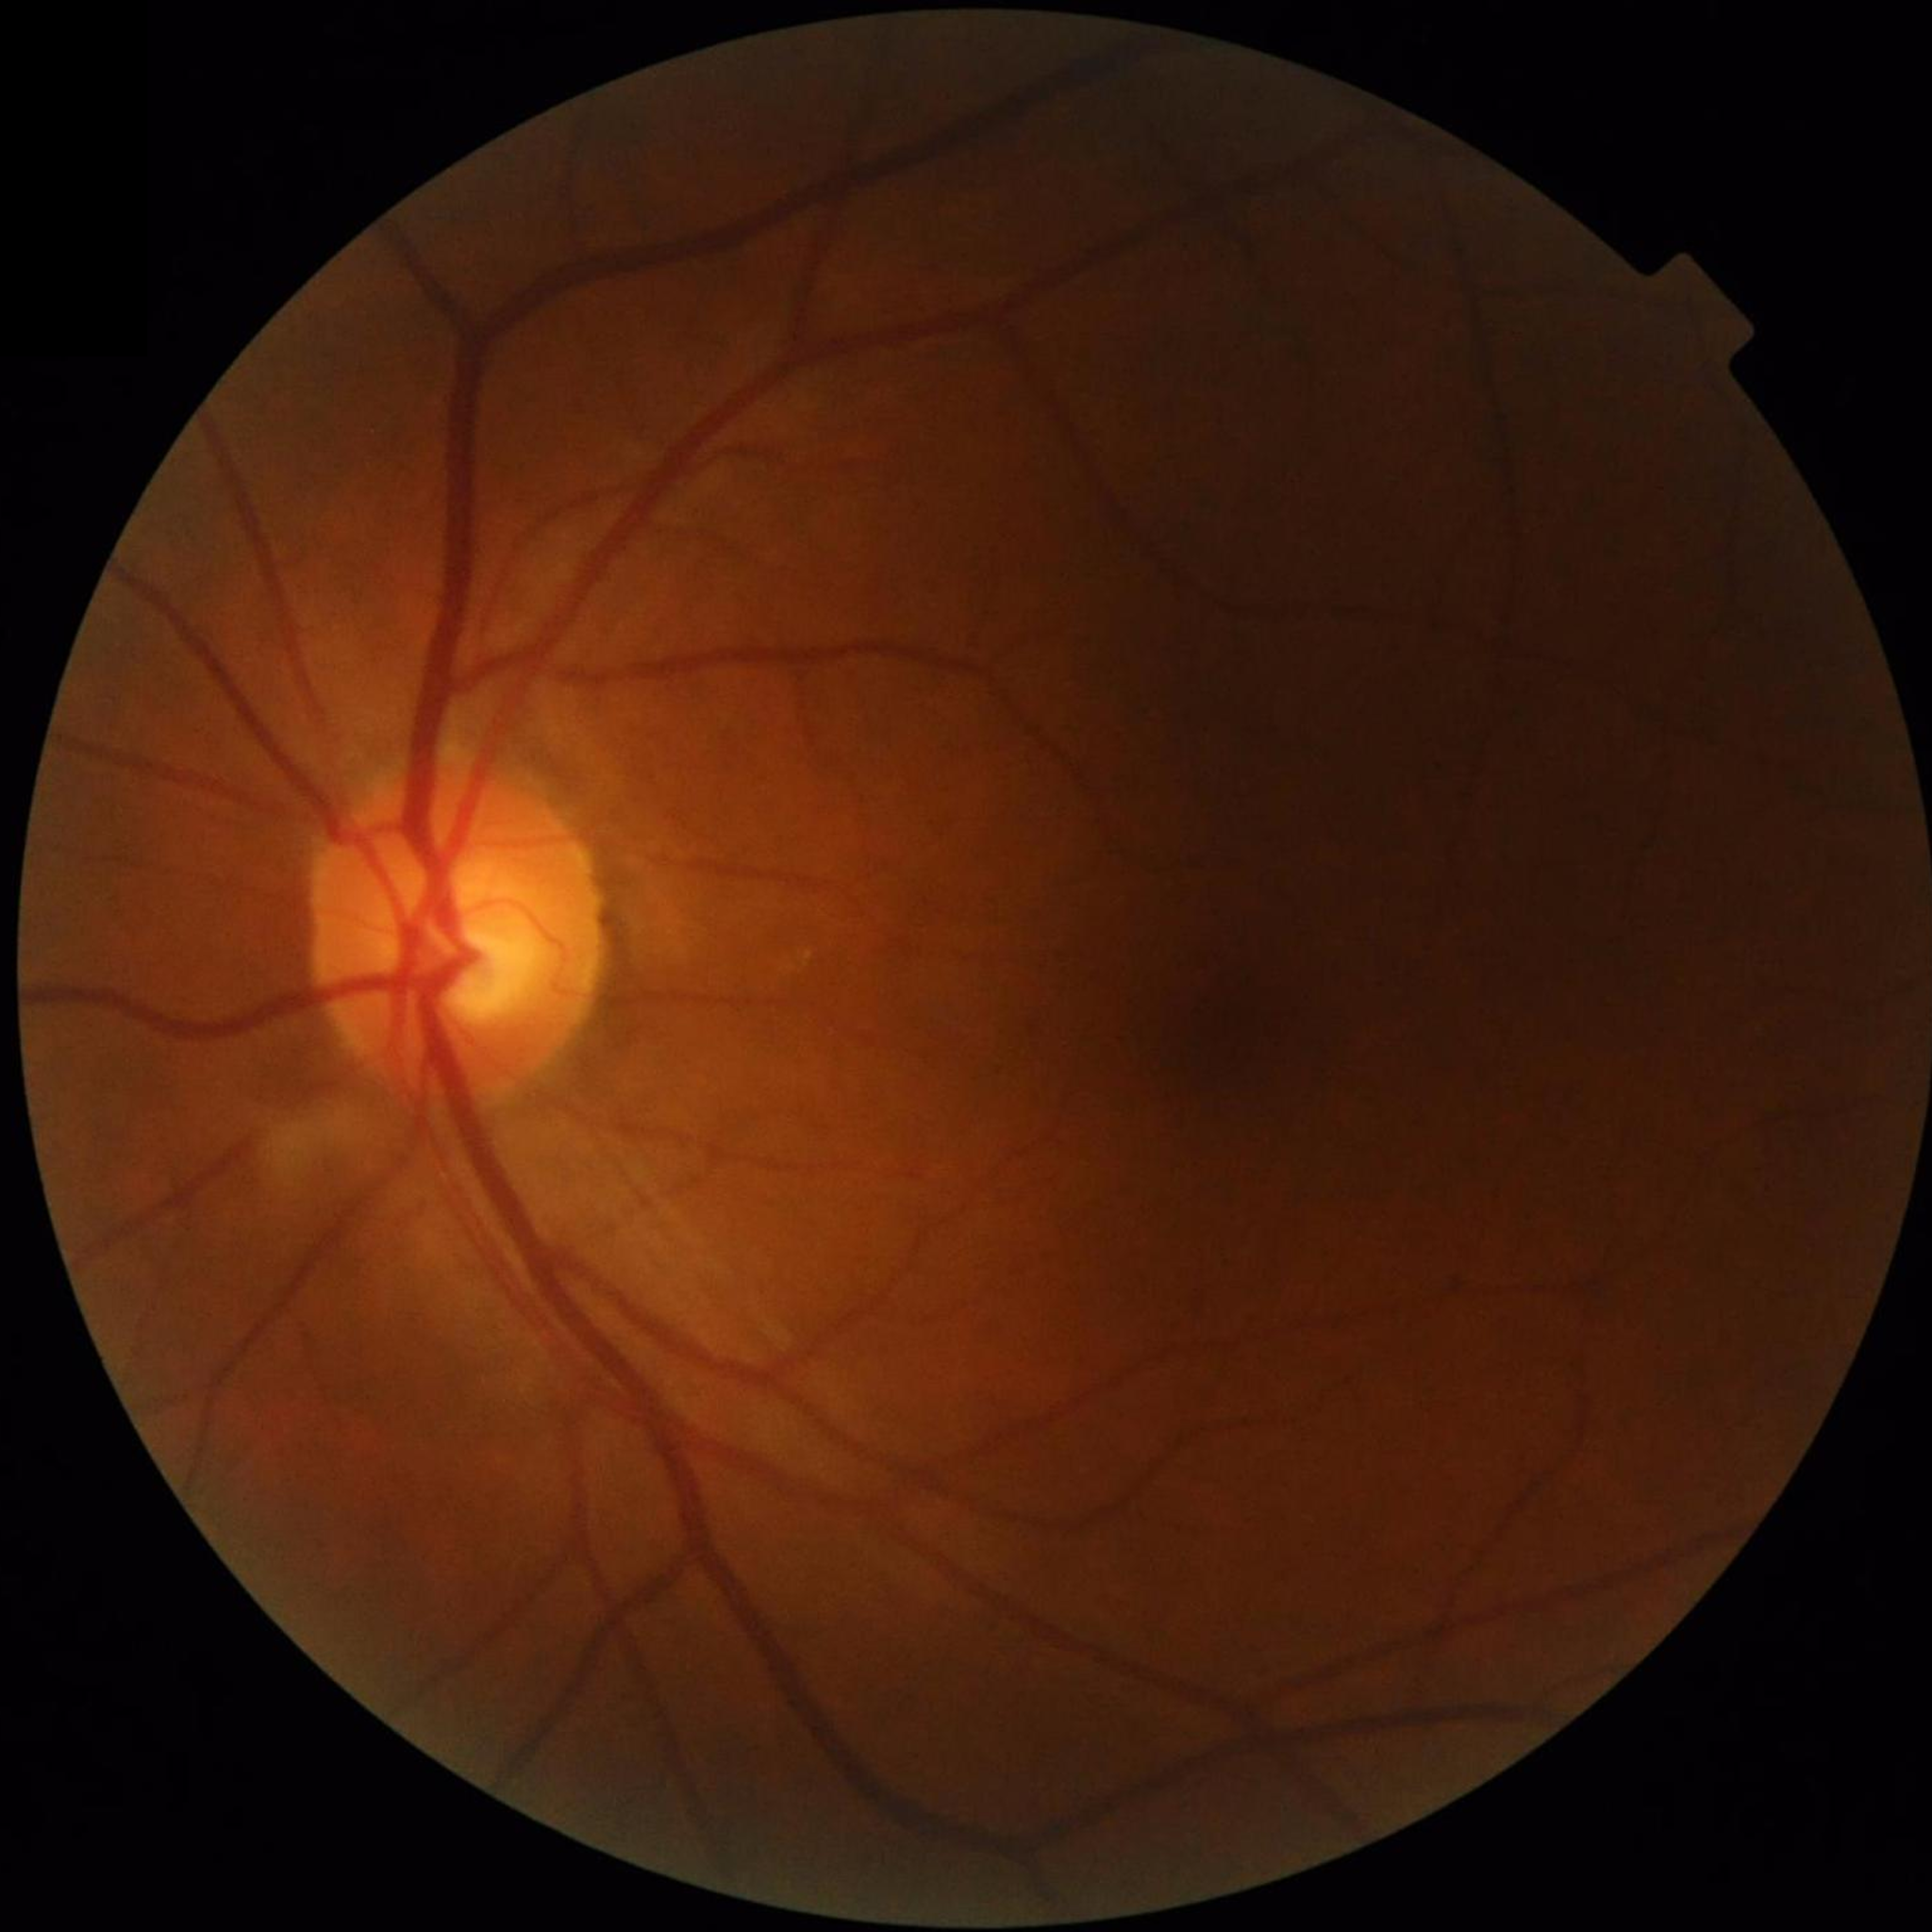

Diagnosis = control (no AMD/DR/glaucoma)